Davis DR grading · FOV: 45 degrees: 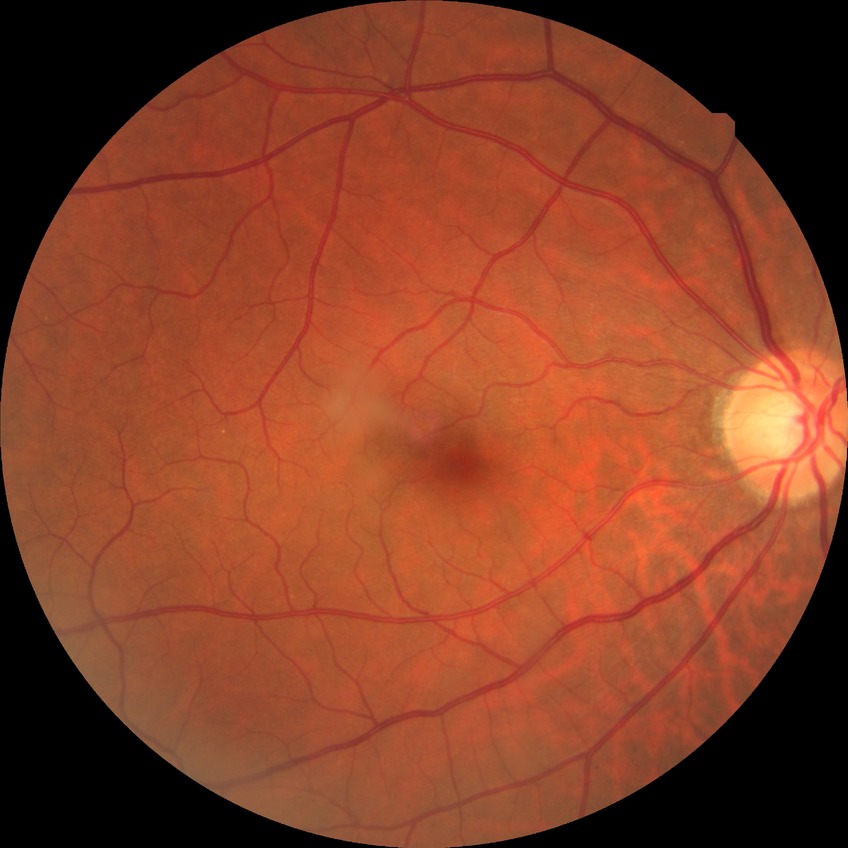 Diabetic retinopathy (DR) is no diabetic retinopathy (NDR).